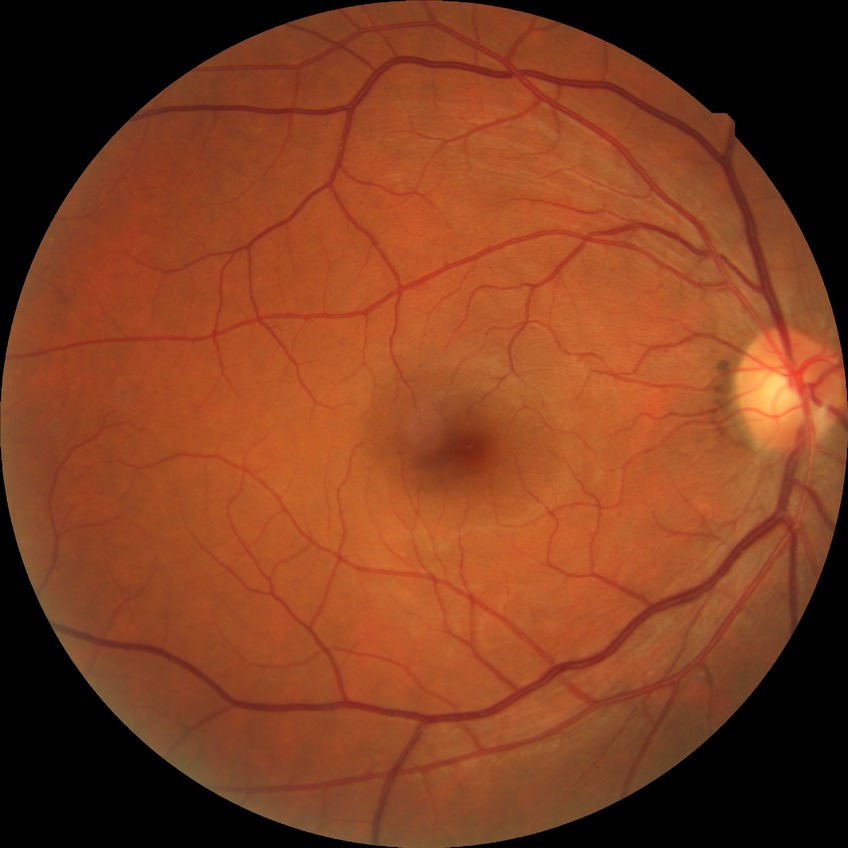

Diabetic retinopathy (DR) is no diabetic retinopathy (NDR).